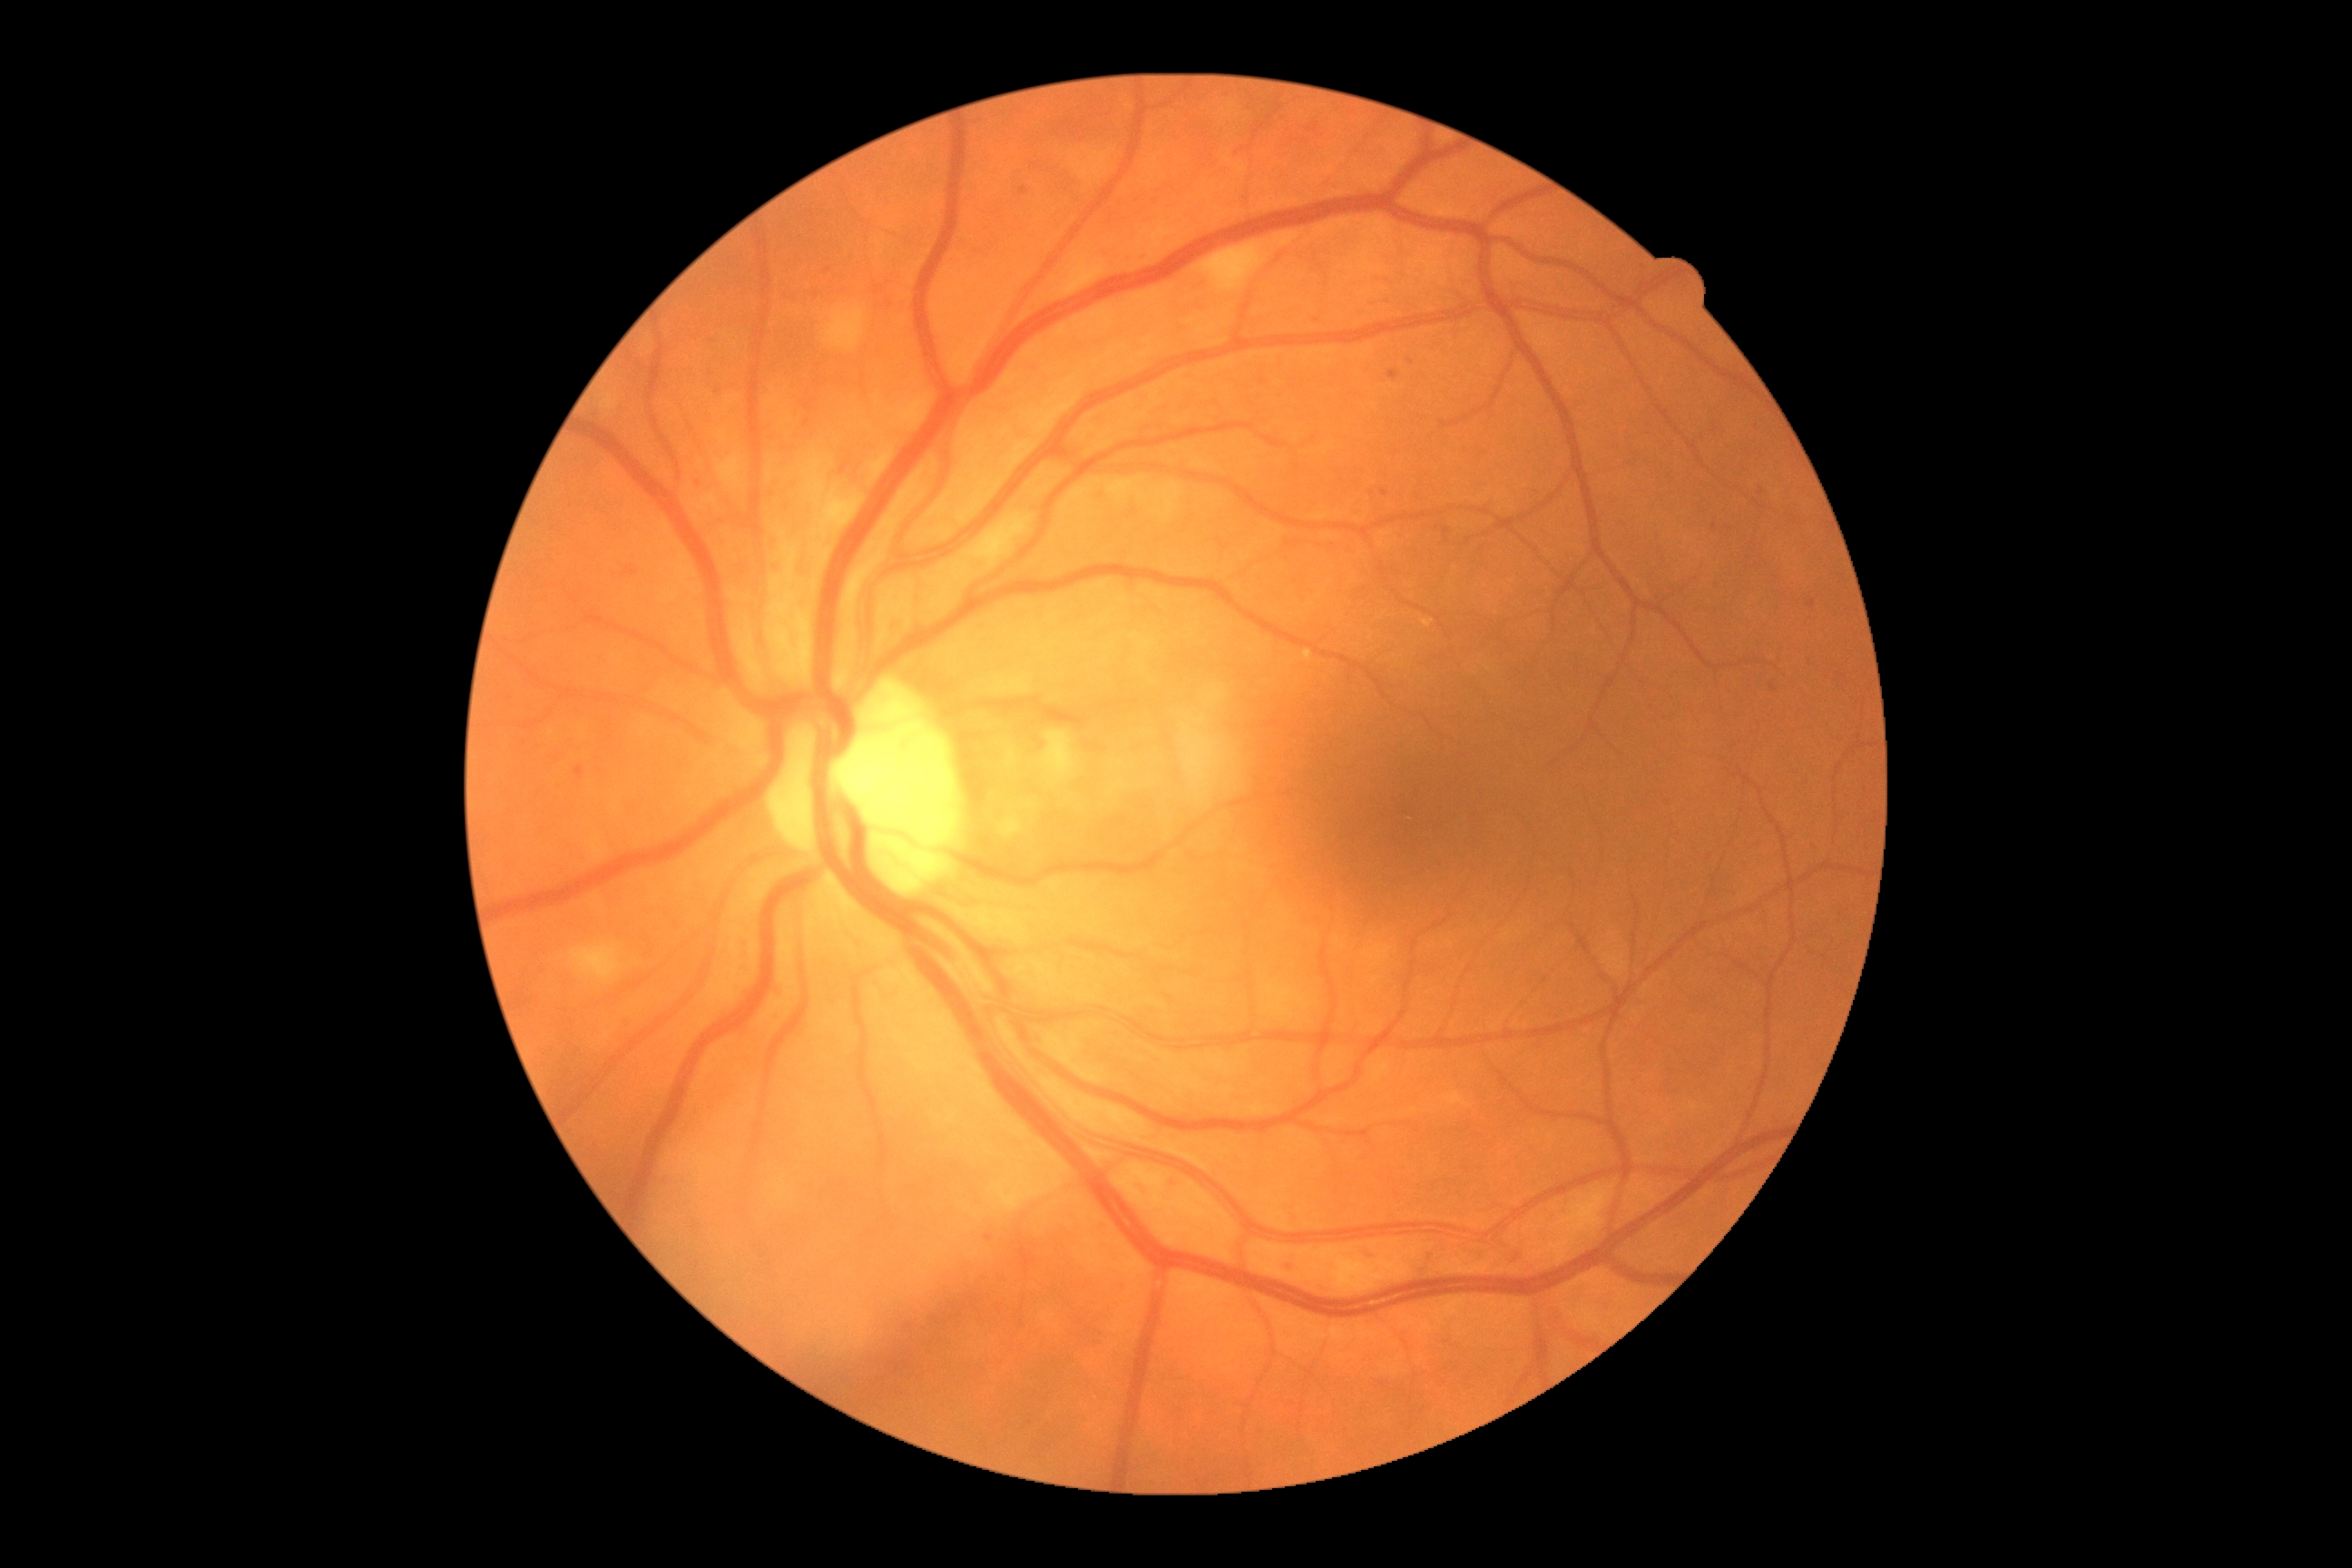

{"dr_grade": "moderate NPDR (2)", "dr_category": "non-proliferative diabetic retinopathy"}